2048 x 1536 pixels — 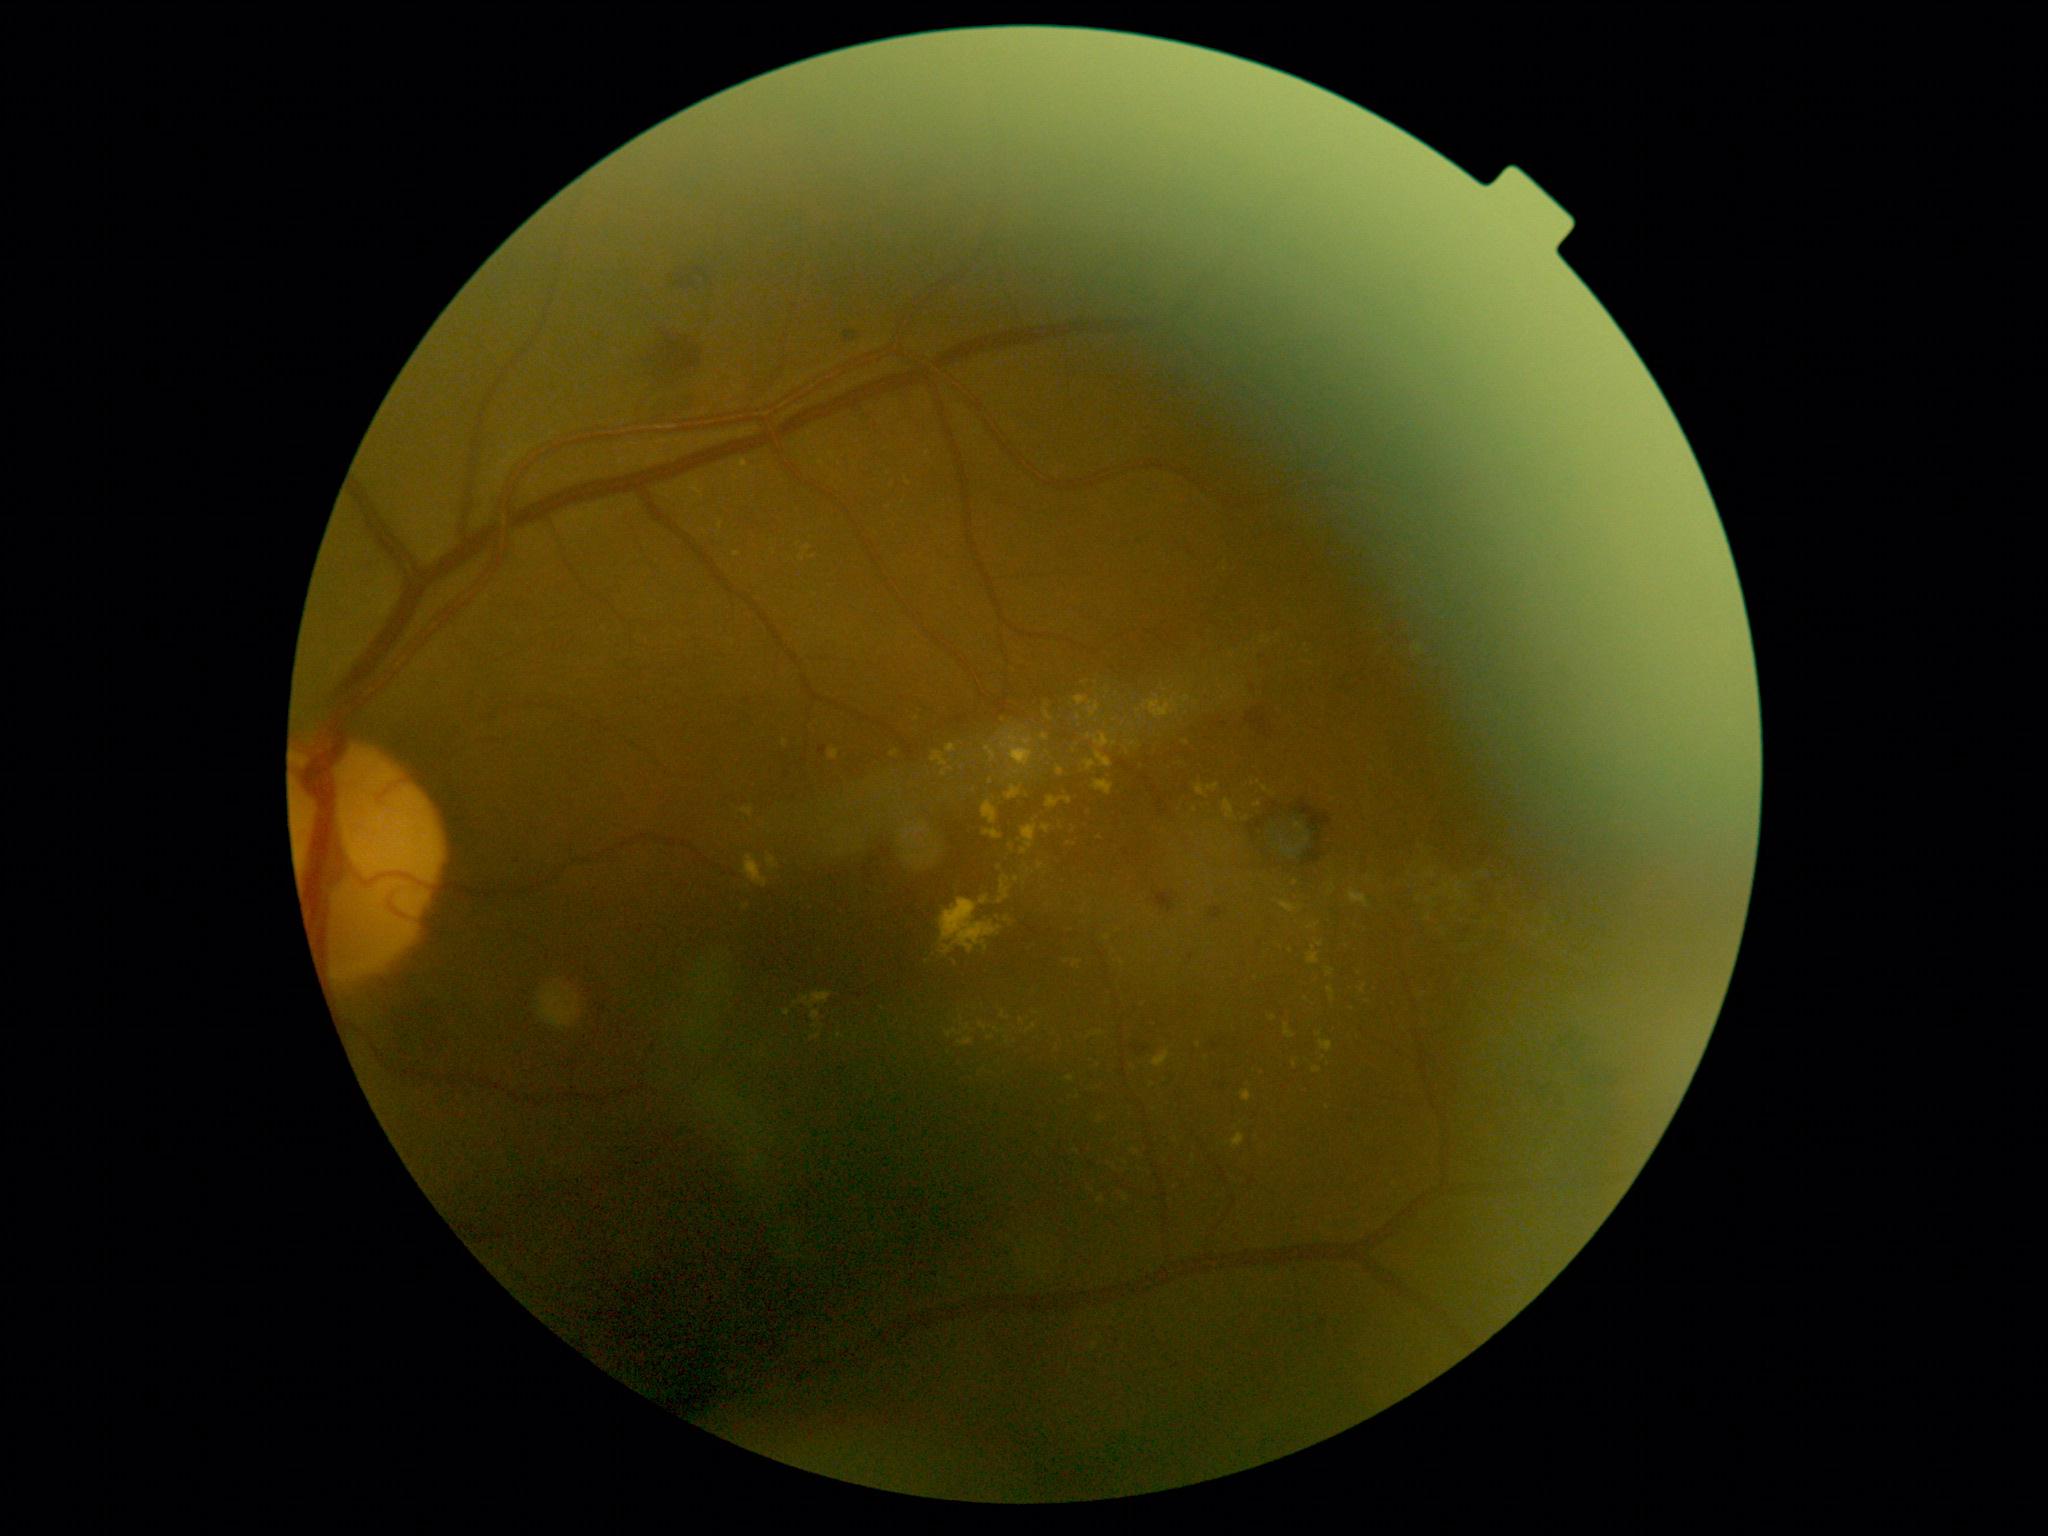

Diabetic retinopathy severity is grade 2 (moderate NPDR); non-proliferative diabetic retinopathy
A subset of detected lesions:
- hard exudates (partial): x1=982 y1=801 x2=998 y2=824 | x1=743 y1=856 x2=769 y2=888 | x1=979 y1=1023 x2=987 y2=1033 | x1=812 y1=1011 x2=821 y2=1021 | x1=767 y1=856 x2=779 y2=869 | x1=1073 y1=961 x2=1082 y2=968 | x1=1223 y1=800 x2=1235 y2=820 | x1=741 y1=808 x2=754 y2=817 | x1=1097 y1=1198 x2=1105 y2=1204
- Smaller hard exudates around (1078; 1152) | (1041; 867) | (1008; 920) | (1247; 819) | (1079; 718) | (1037; 1014) | (923; 841) | (1022; 731) | (1327; 1108)